35° FOV before cropping; mydriatic; ONH-centered crop from a color fundus image:
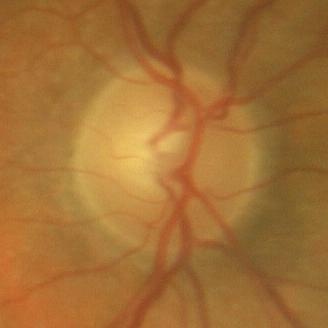

No glaucoma.